1240 x 1240 pixels. Phoenix ICON wide-field infant fundus image: 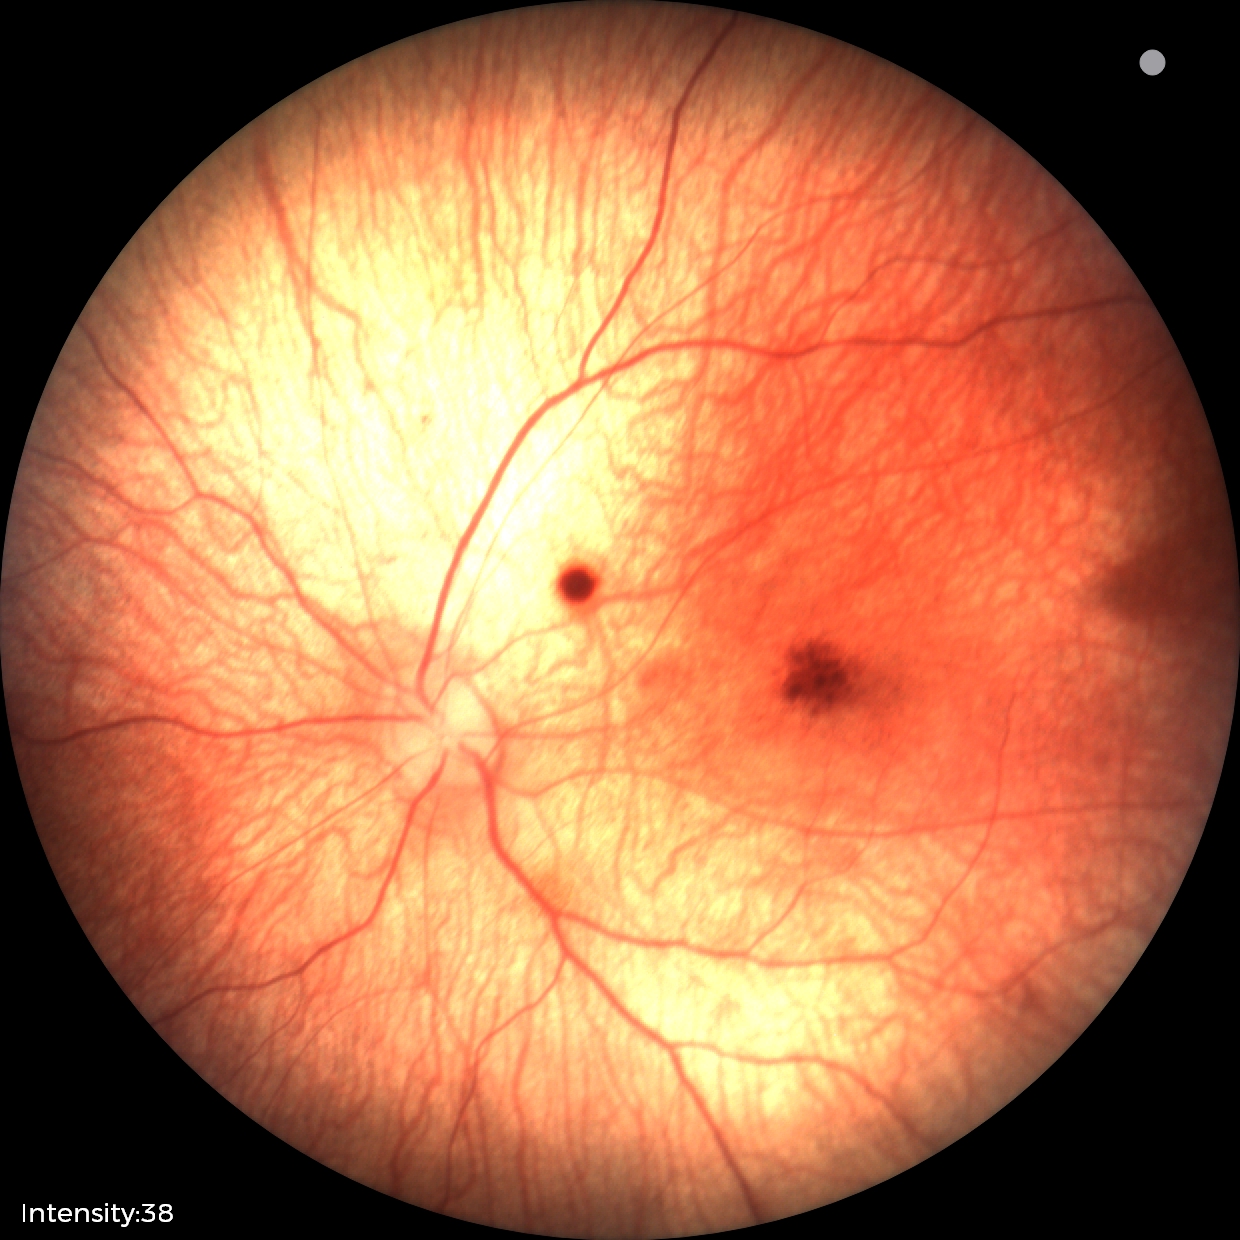 Screening series with retinal hemorrhages.